2352x1568 · 45° field of view:
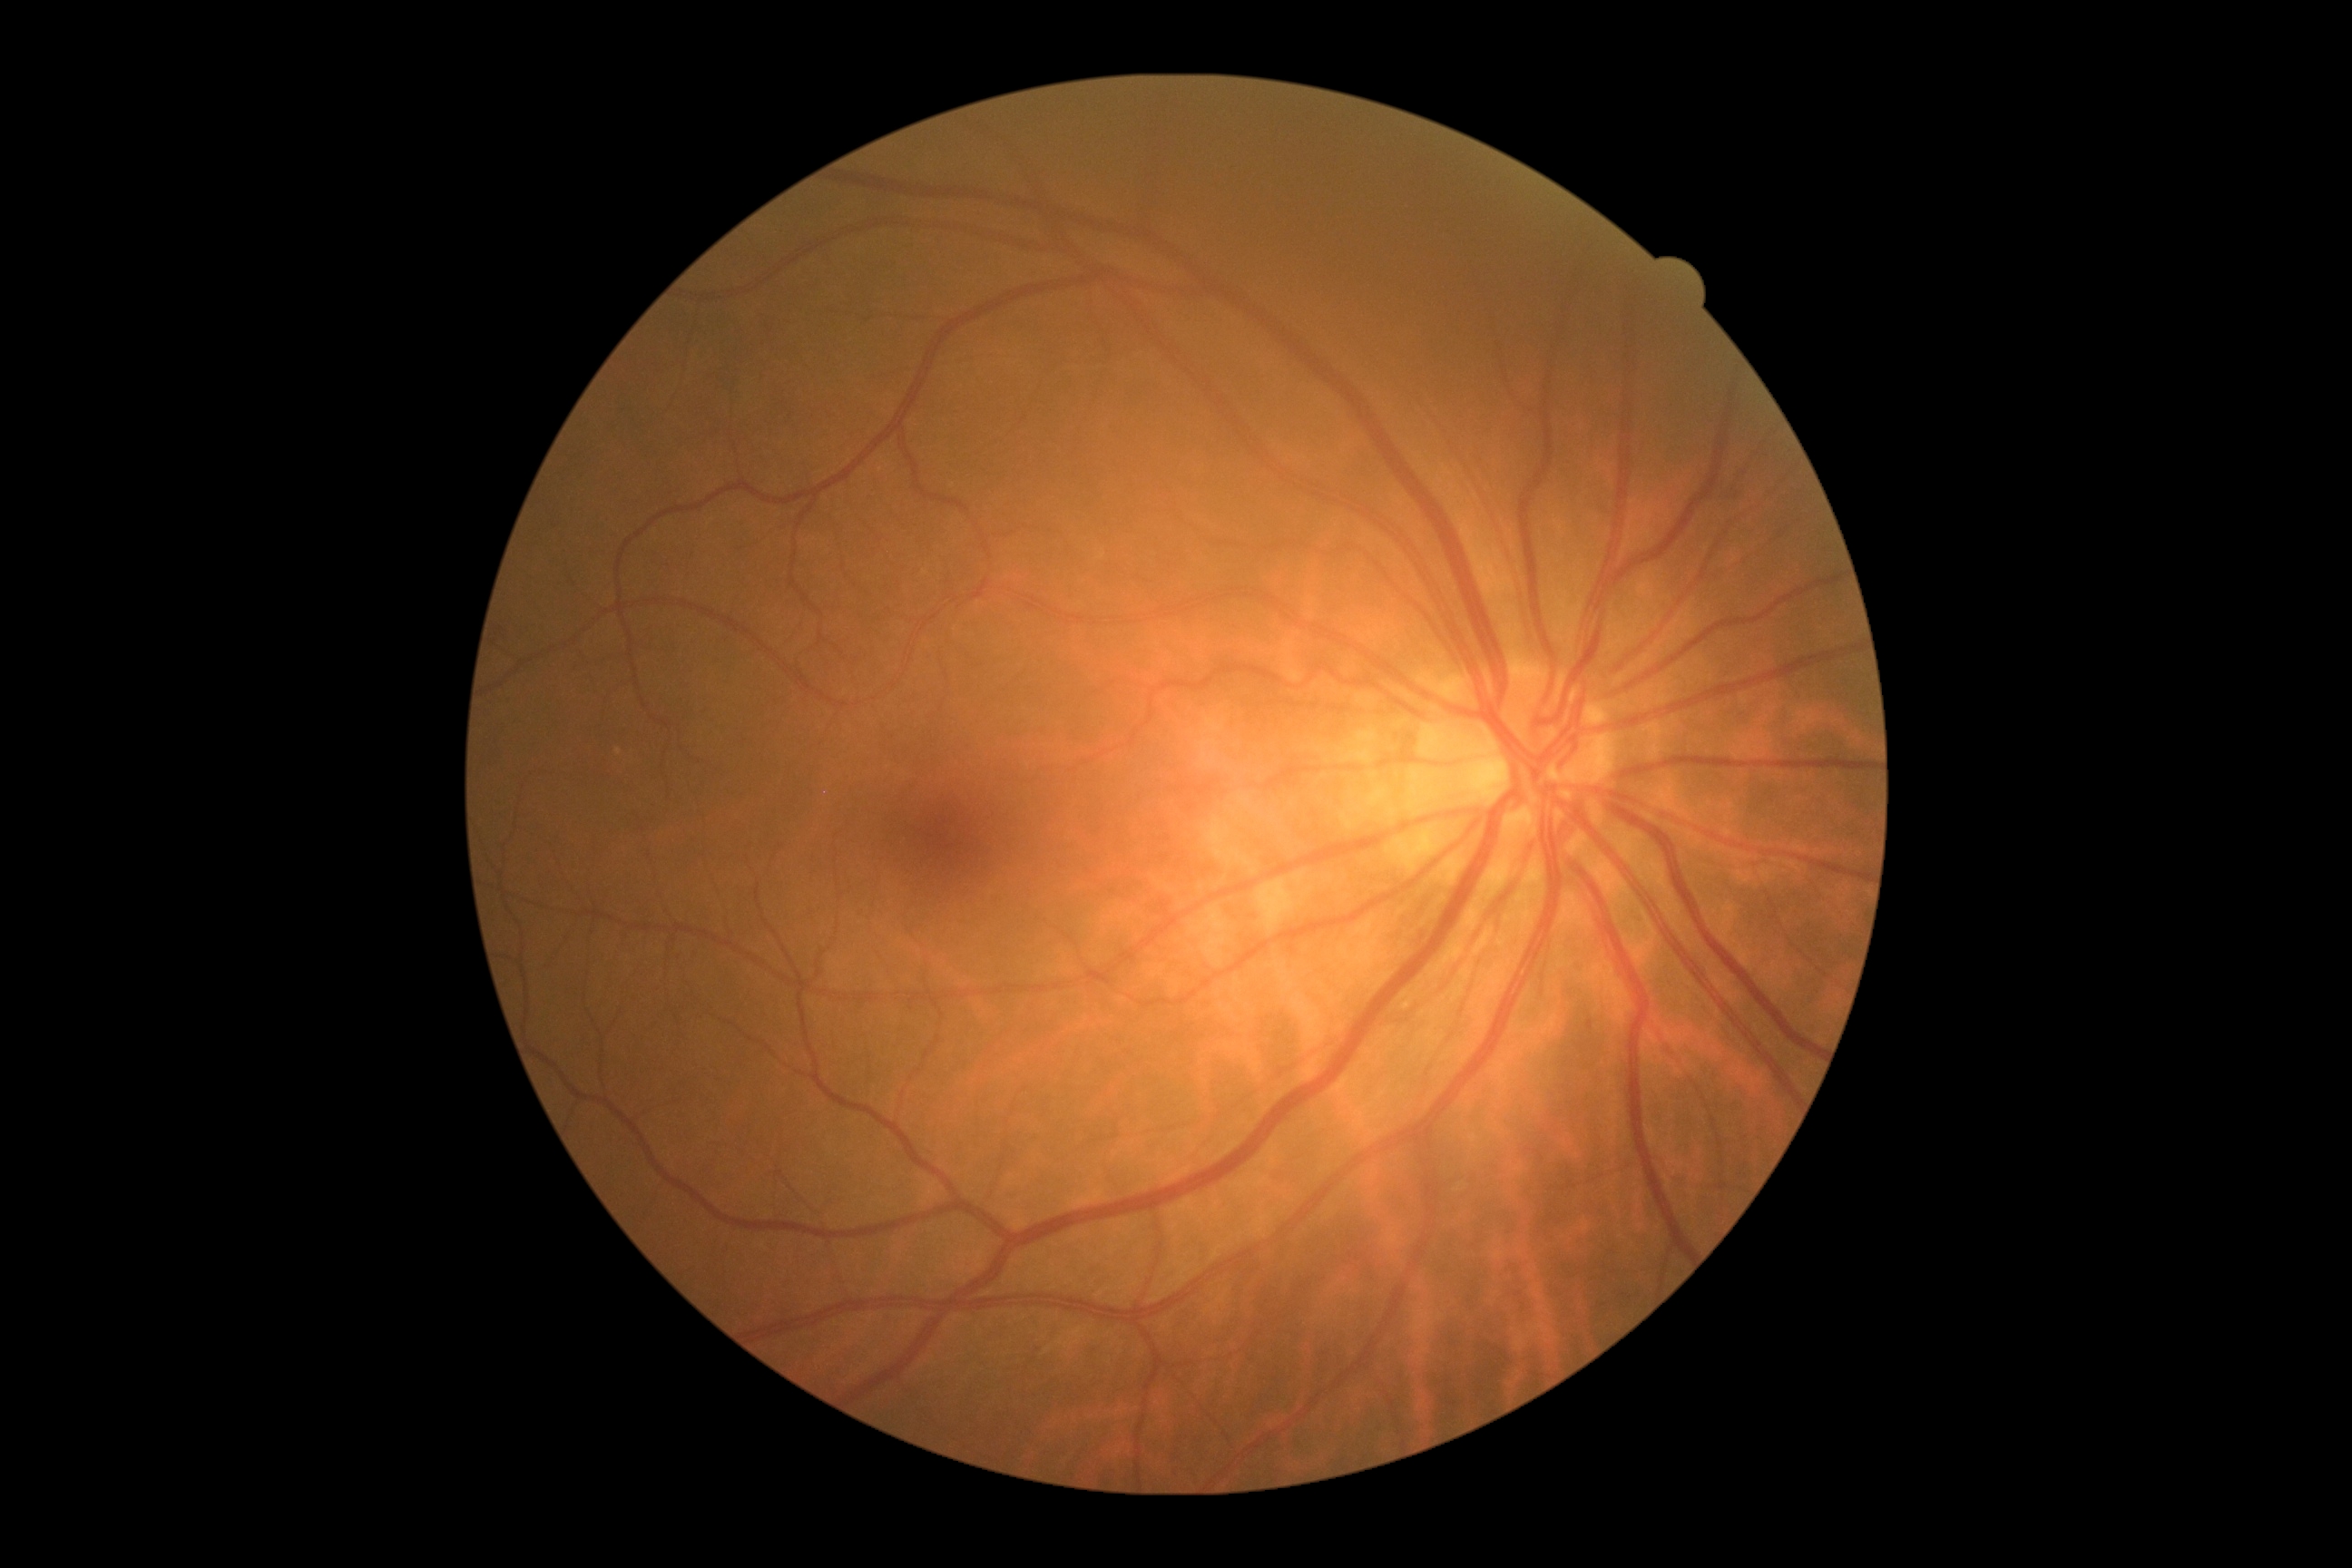

DR grade is mild NPDR (1).